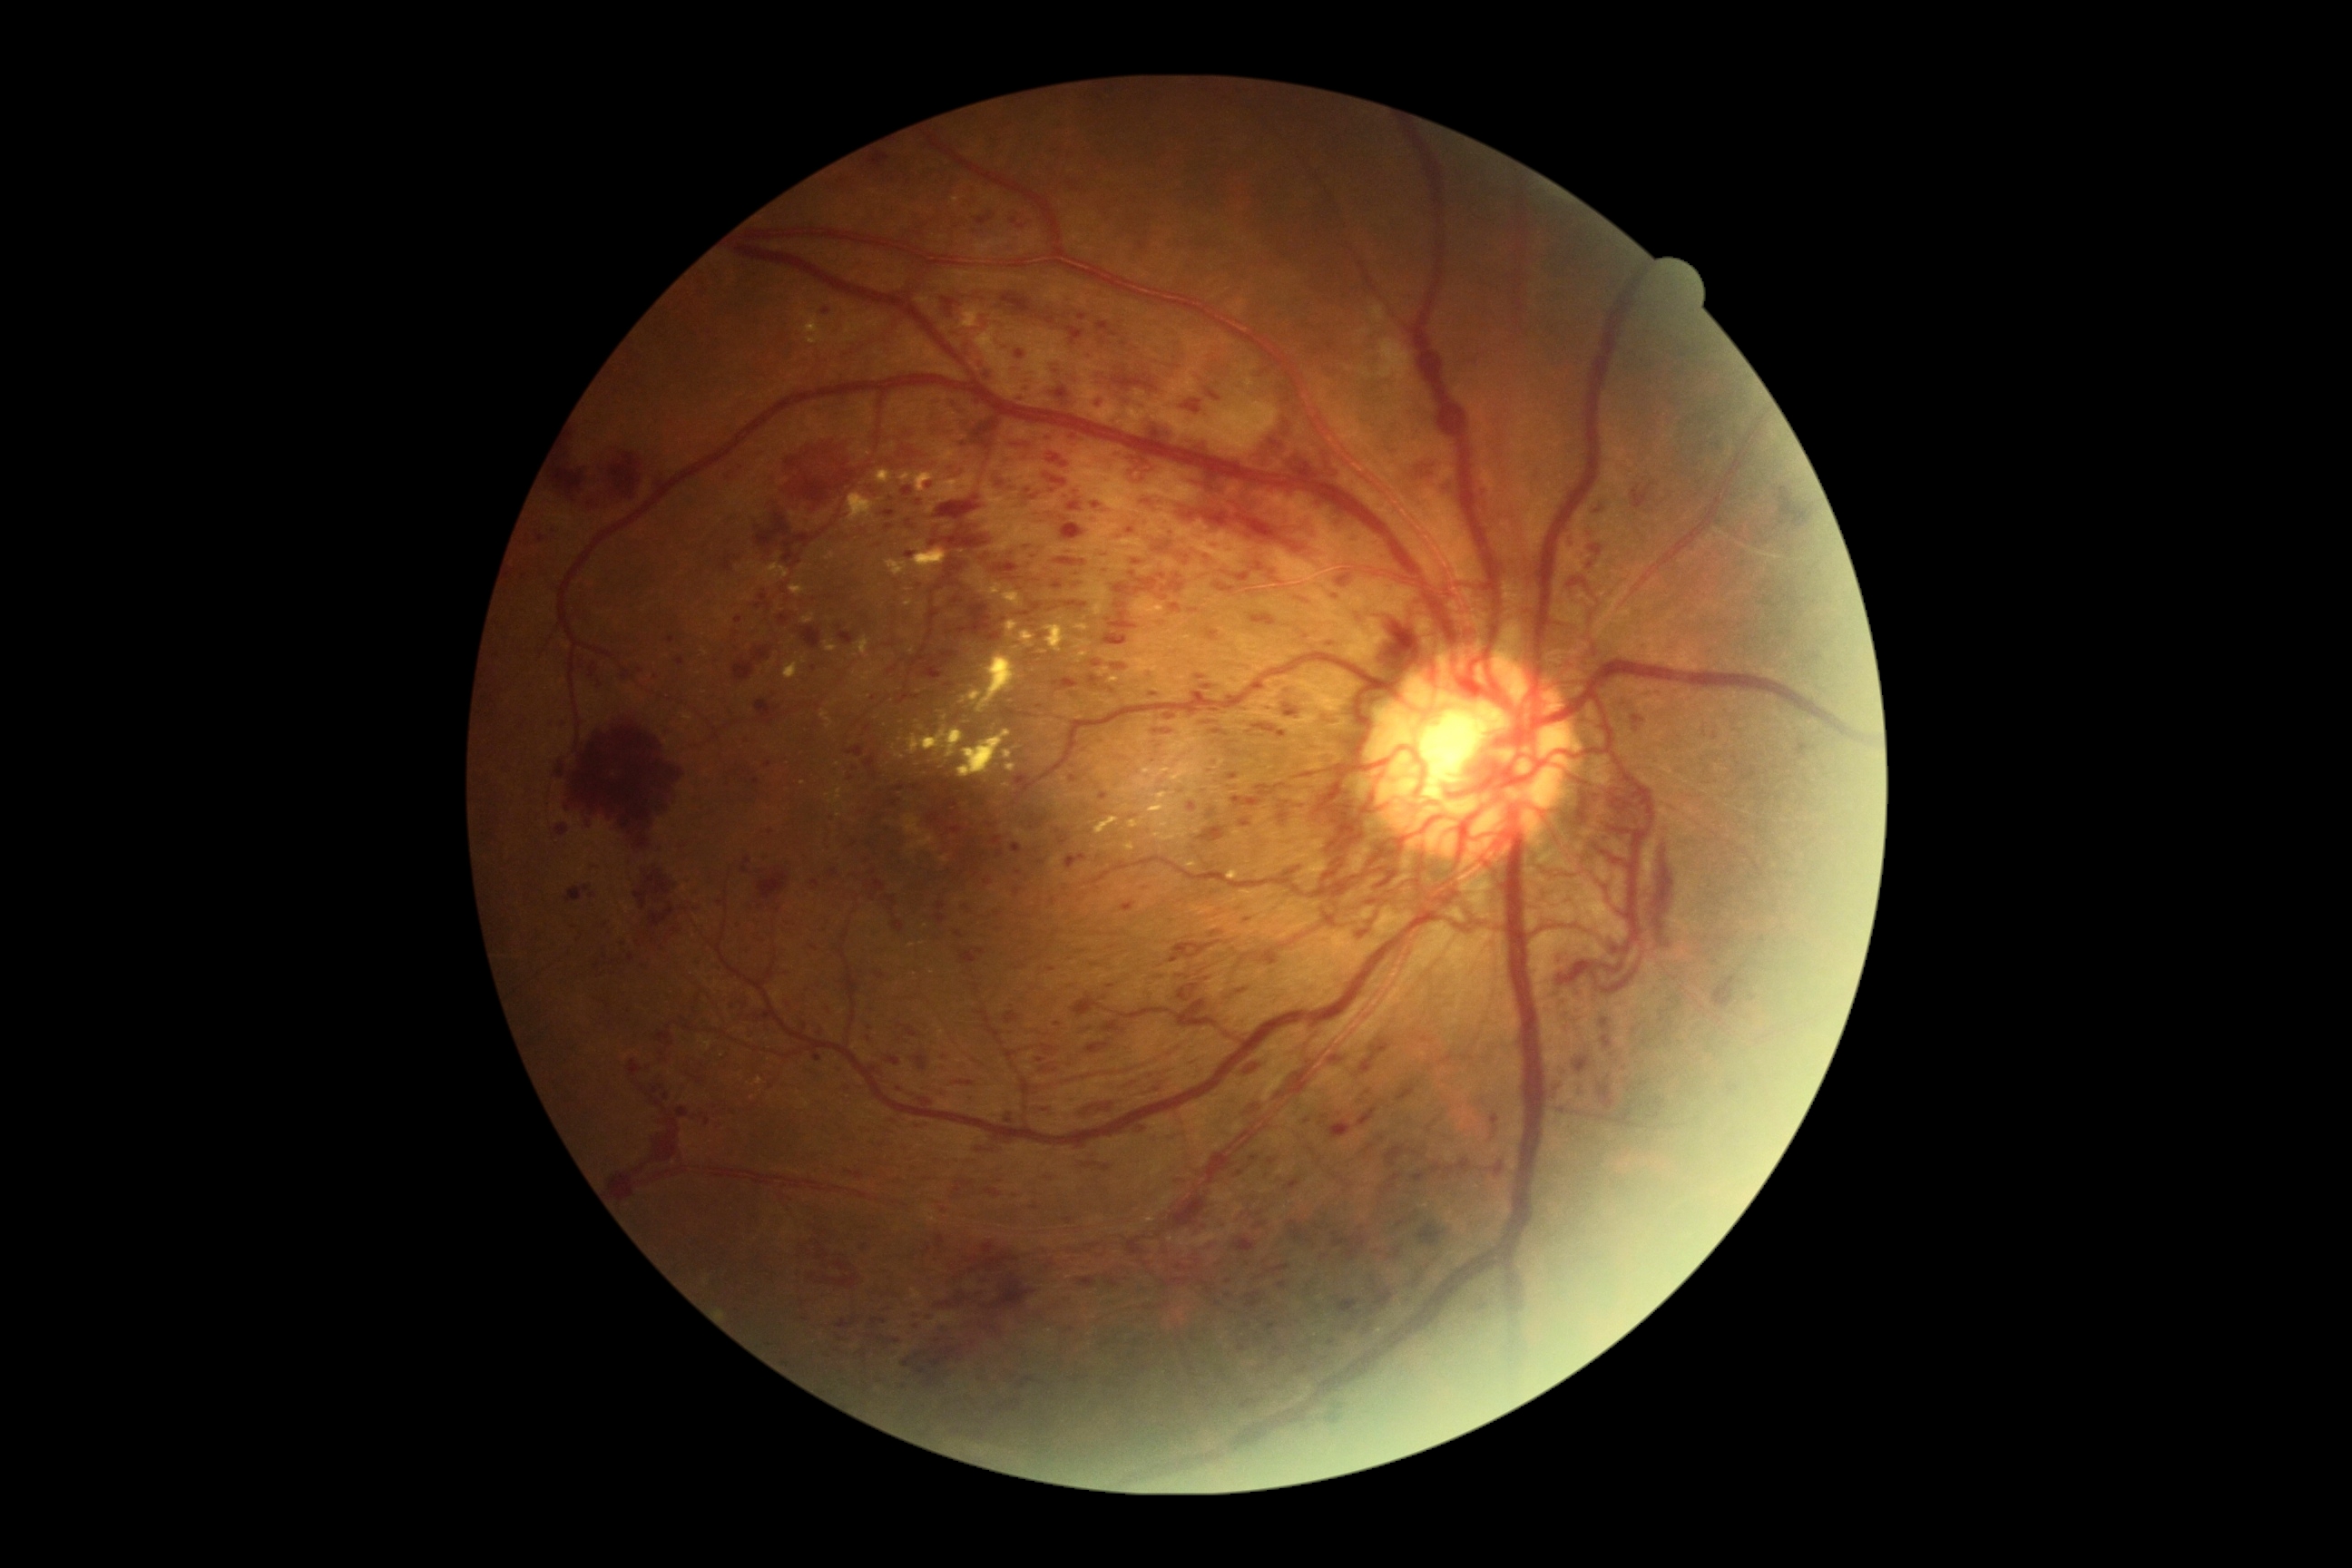
Diabetic retinopathy is grade 4 (PDR). Hemorrhages are present, including at [left=1235, top=573, right=1251, bottom=583] | [left=1182, top=400, right=1202, bottom=415] | [left=1255, top=1222, right=1268, bottom=1230] | [left=1266, top=954, right=1284, bottom=968] | [left=1338, top=1298, right=1362, bottom=1322] | [left=1228, top=774, right=1239, bottom=781] | [left=1237, top=990, right=1248, bottom=995] | [left=1391, top=1173, right=1404, bottom=1182] | [left=1064, top=1219, right=1072, bottom=1224] | [left=928, top=789, right=975, bottom=836] | [left=936, top=495, right=983, bottom=522] | [left=1204, top=389, right=1220, bottom=402] | [left=1128, top=1237, right=1148, bottom=1259] | [left=1211, top=729, right=1228, bottom=738] | [left=1097, top=322, right=1119, bottom=338] | [left=1001, top=293, right=1035, bottom=315]. Hemorrhages (small, approximate centers) near 1053, 610 | 1643, 1084 | 745, 772.